Camera: NIDEK AFC-230 · DR severity per modified Davis staging.
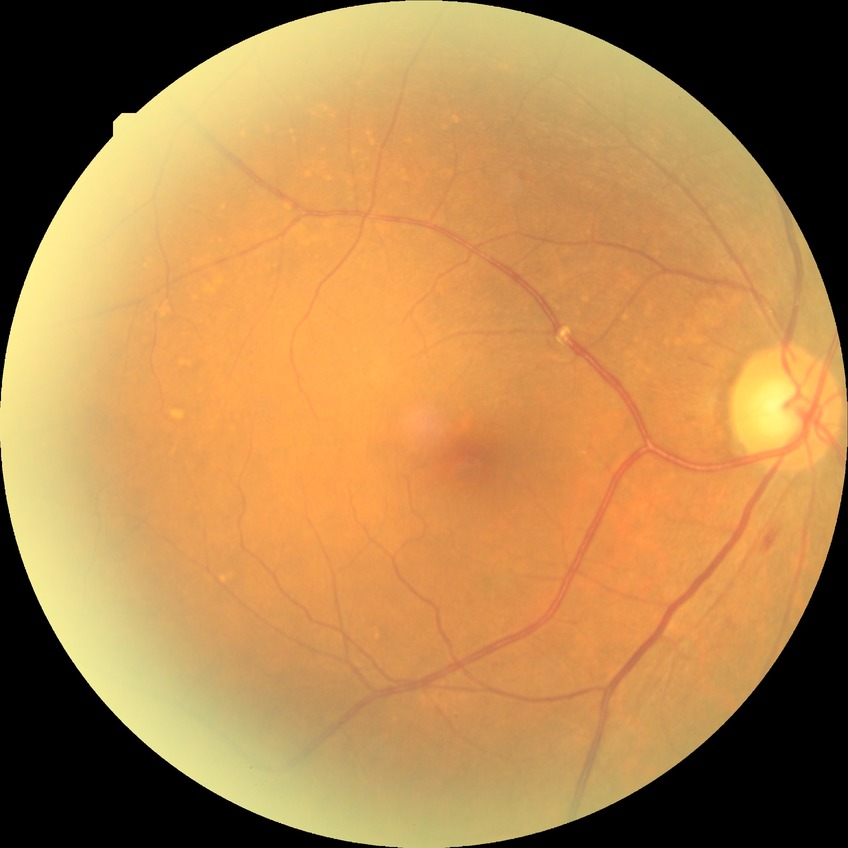
– diabetic retinopathy (DR): simple diabetic retinopathy (SDR)